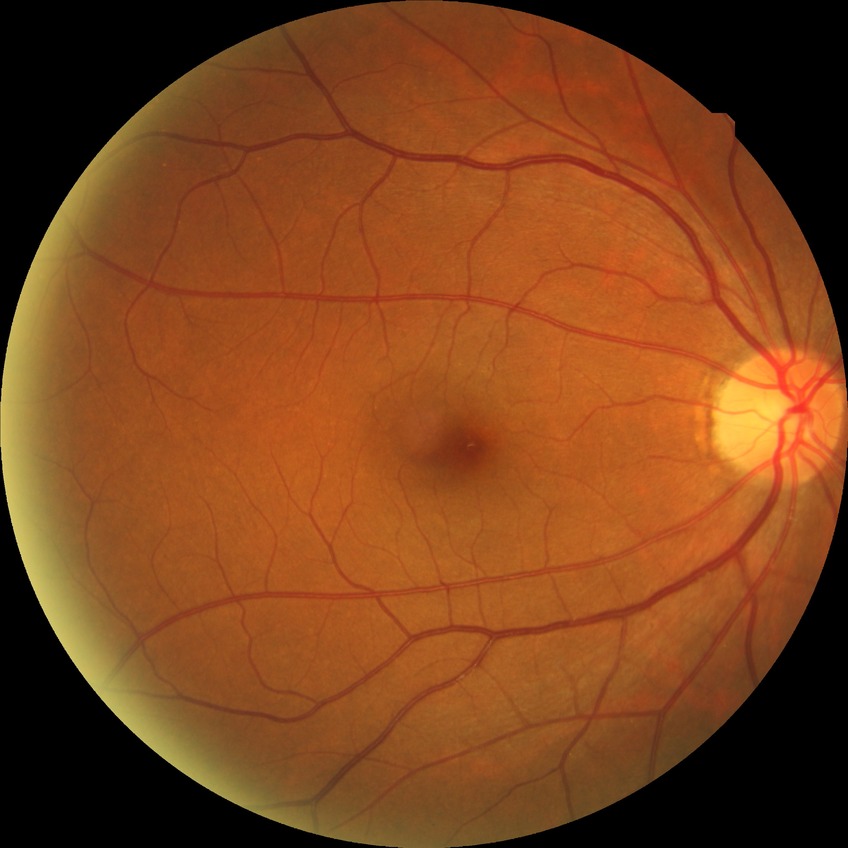 Diabetic retinopathy (DR) is NDR (no diabetic retinopathy).